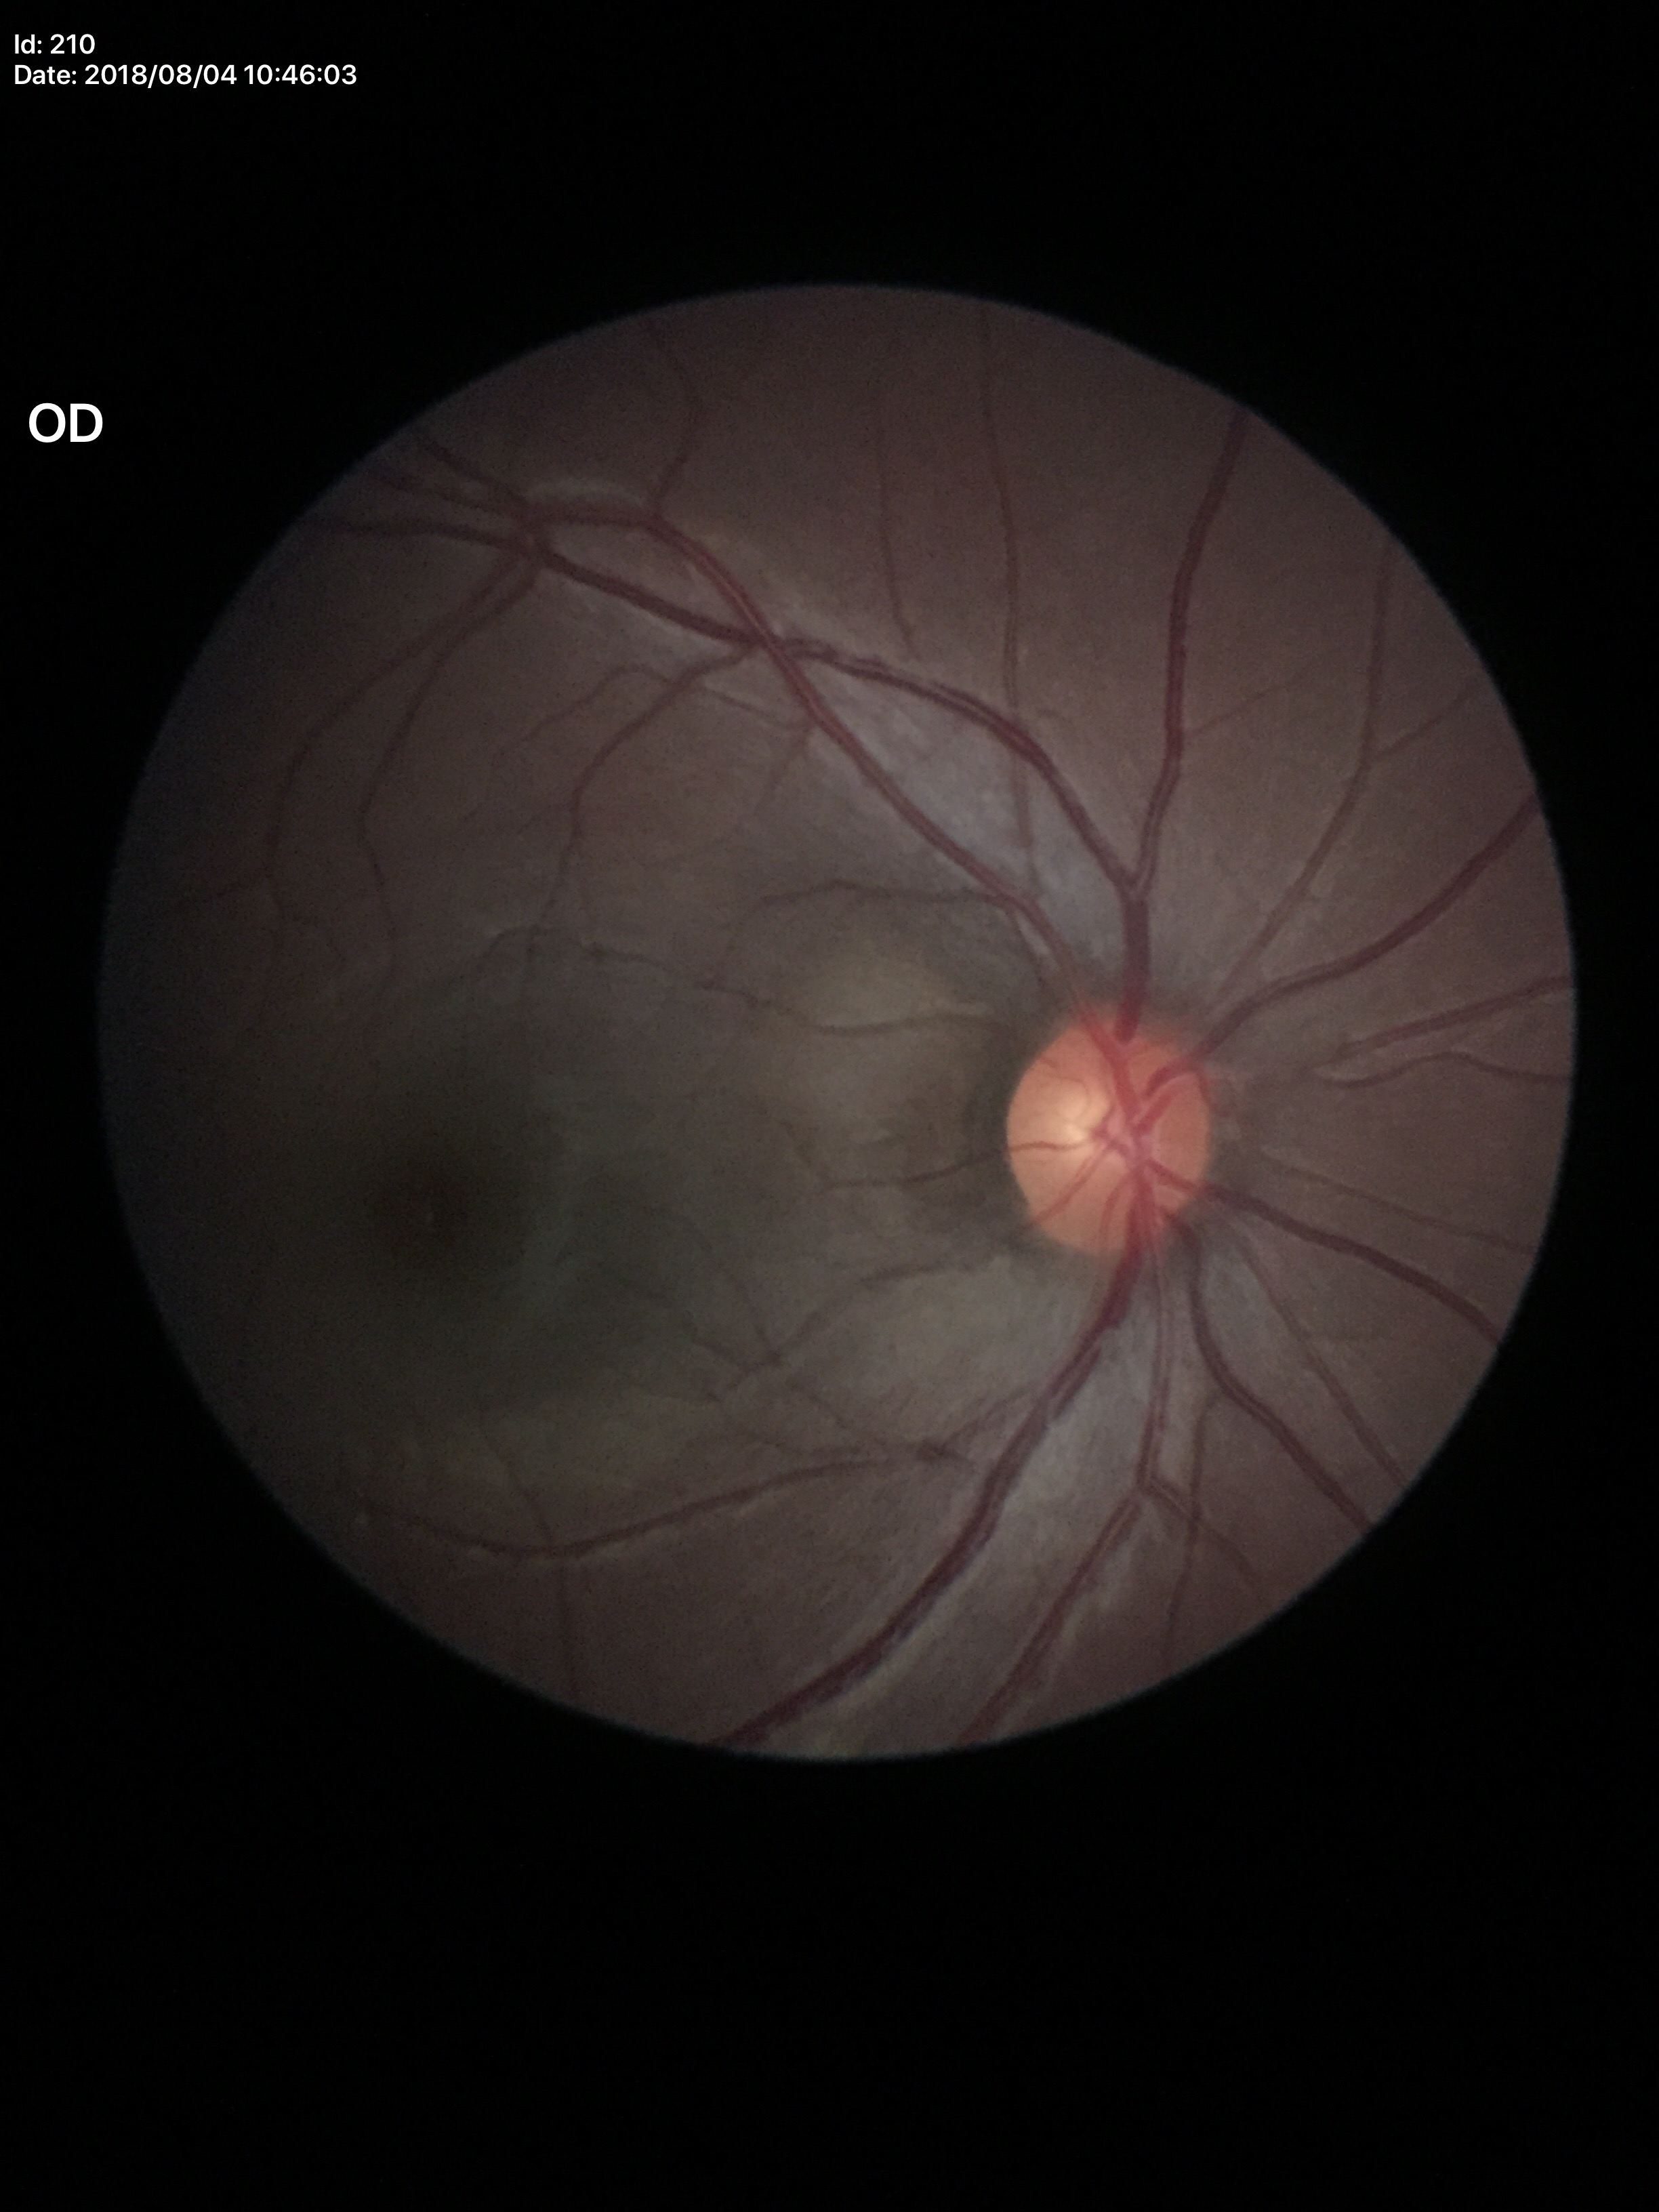
Glaucoma impression: negative
vertical CDR: 0.49
horizontal cup-to-disc ratio: 0.52